2352x1568.
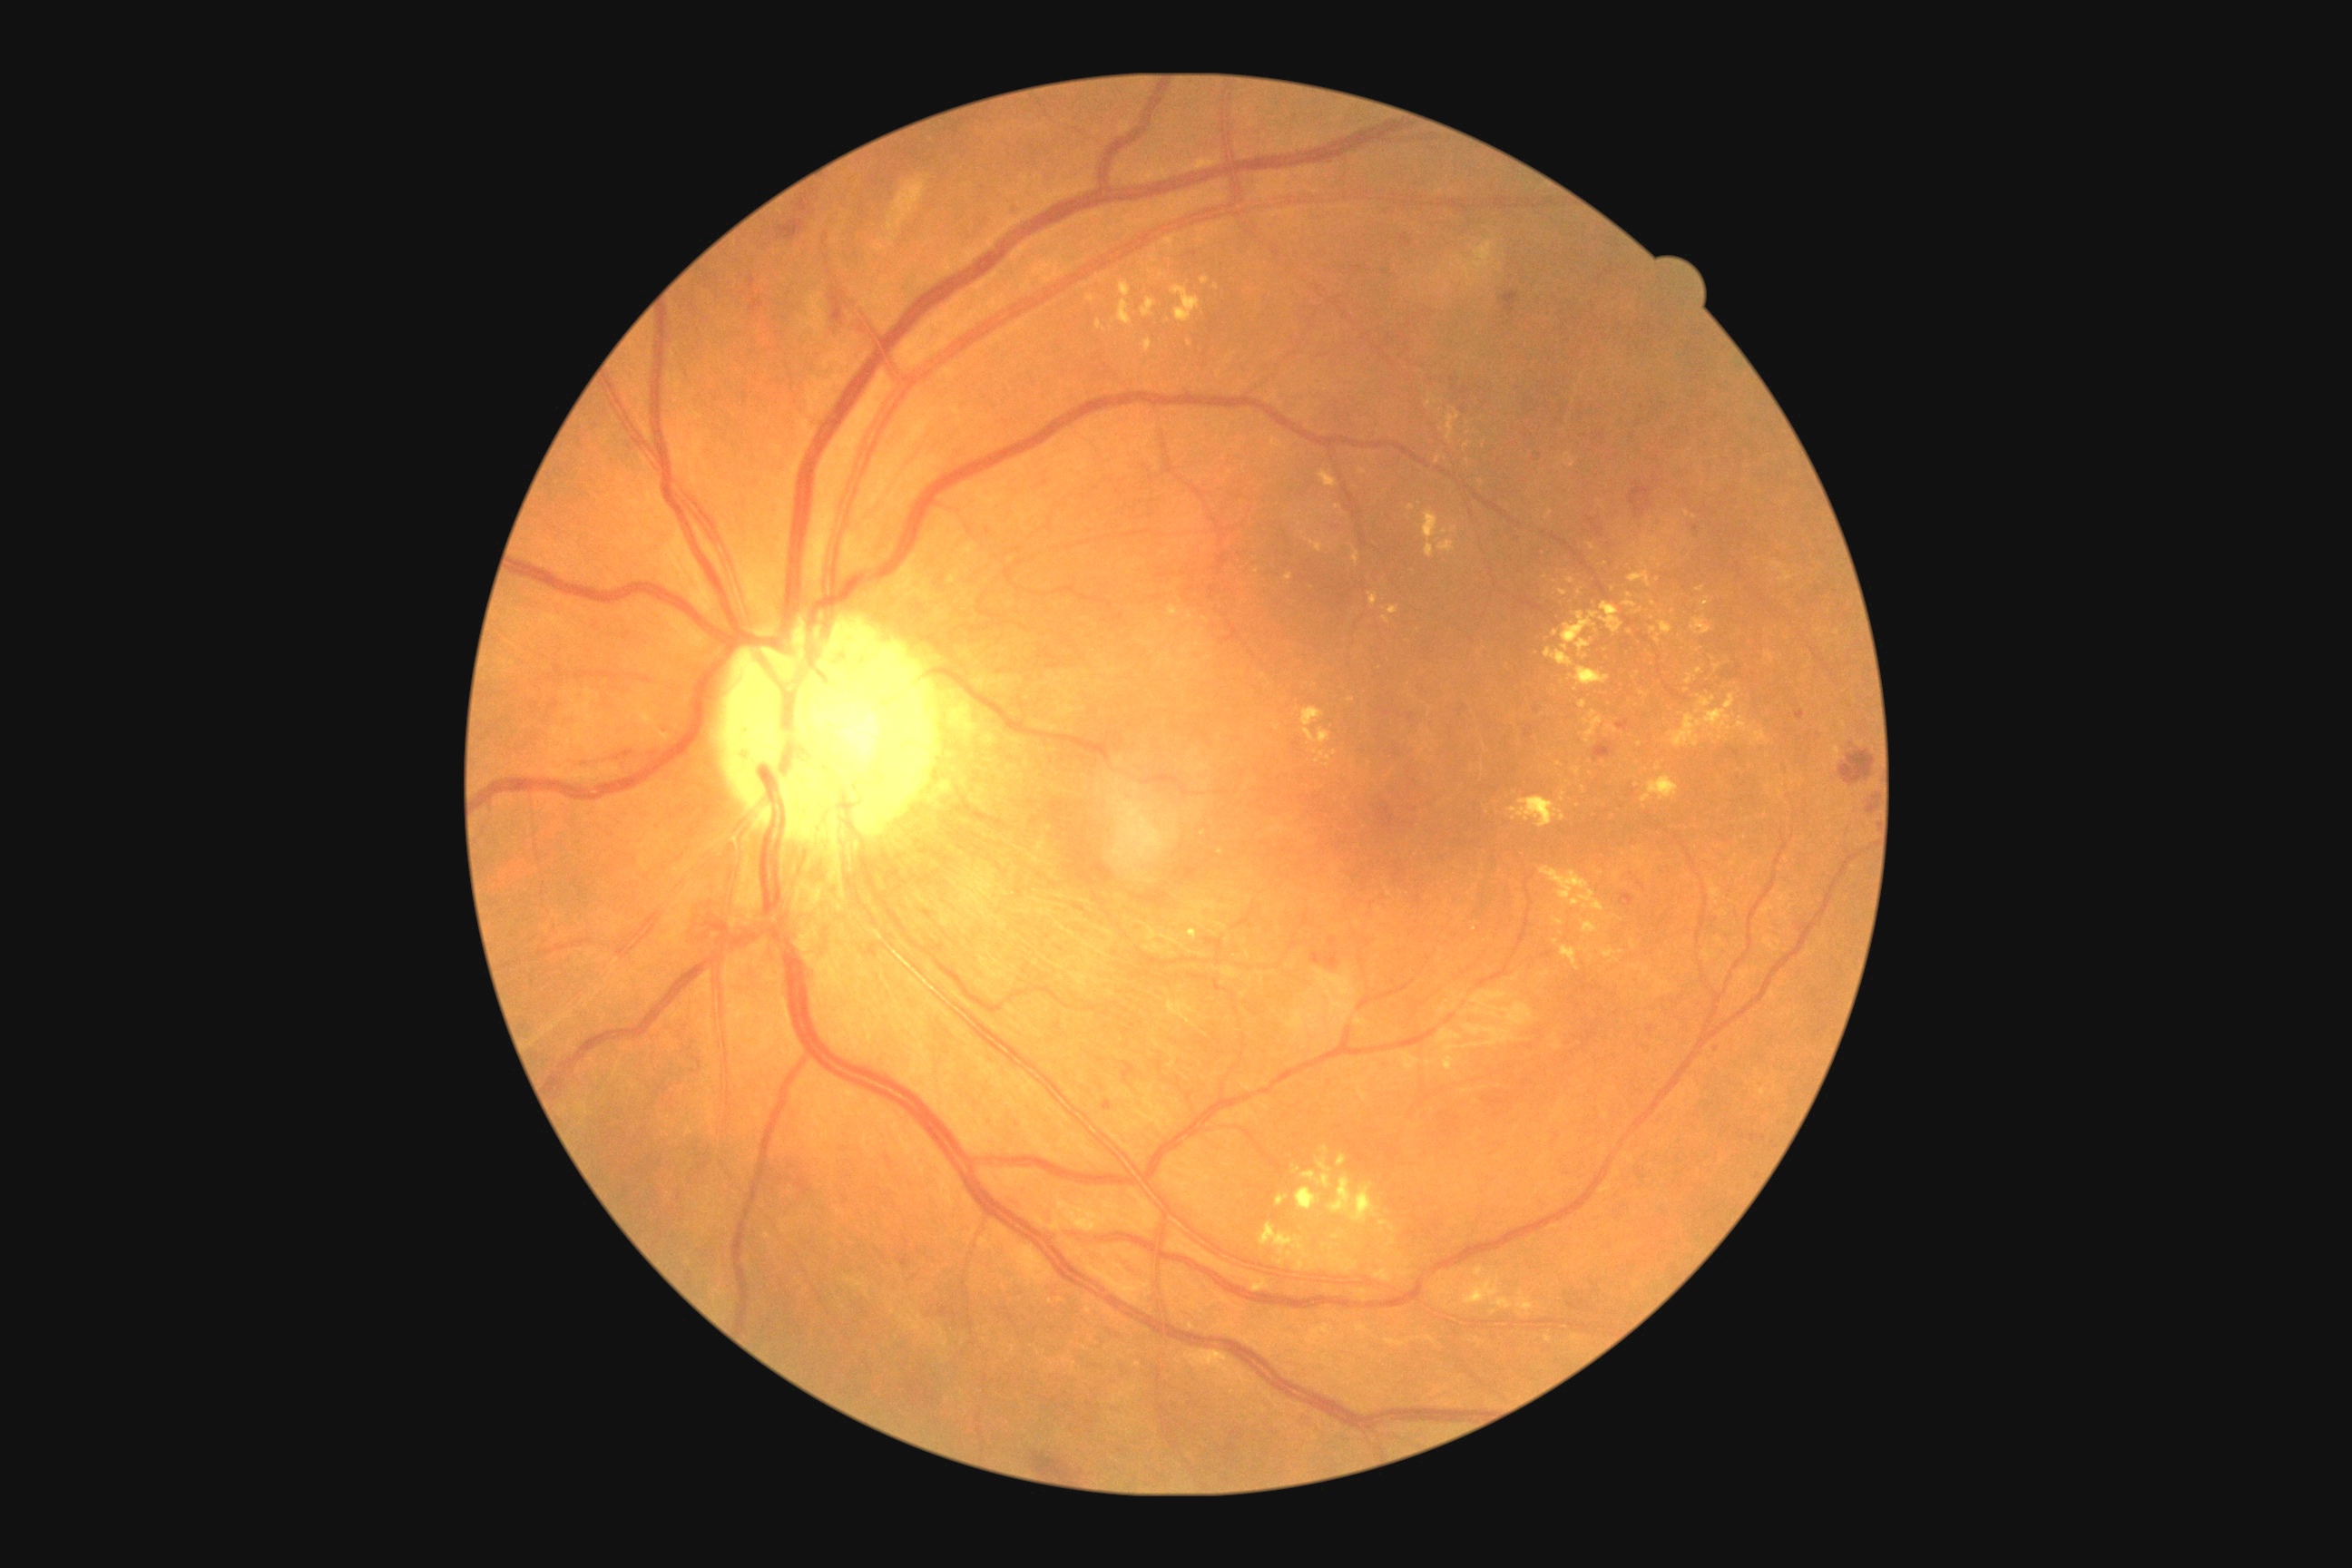 Retinopathy is grade 2 (moderate NPDR).
Hard exudates include those at rect(1569, 667, 1611, 687), rect(1629, 571, 1652, 589), rect(1696, 587, 1705, 593), rect(1738, 716, 1750, 732), rect(1260, 1222, 1311, 1259), rect(1271, 438, 1284, 449), rect(1578, 701, 1587, 709), rect(1623, 602, 1636, 607), rect(1320, 471, 1337, 487), rect(1337, 1157, 1346, 1166), rect(1295, 1260, 1304, 1271).
Smaller hard exudates around Point(1658, 768), Point(1493, 1312), Point(1482, 482), Point(1327, 765), Point(1363, 472), Point(1640, 745), Point(1698, 671), Point(1338, 507).